Wide-field fundus photograph from neonatal ROP screening.
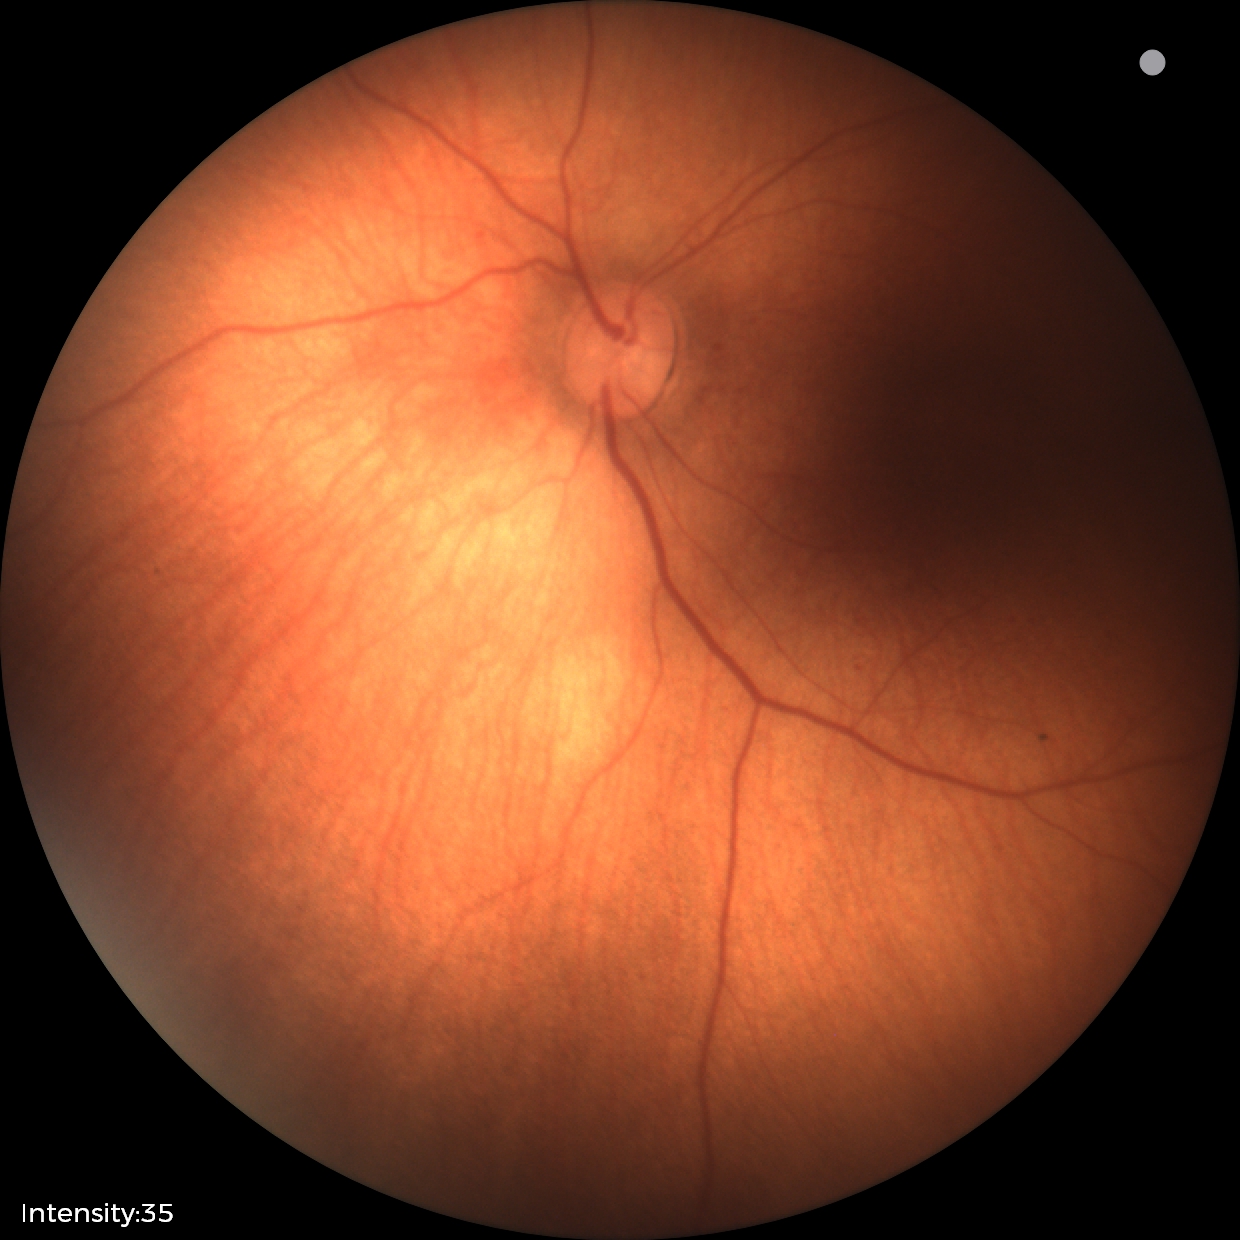
Diagnosis = physiological appearance.